45° FOV.
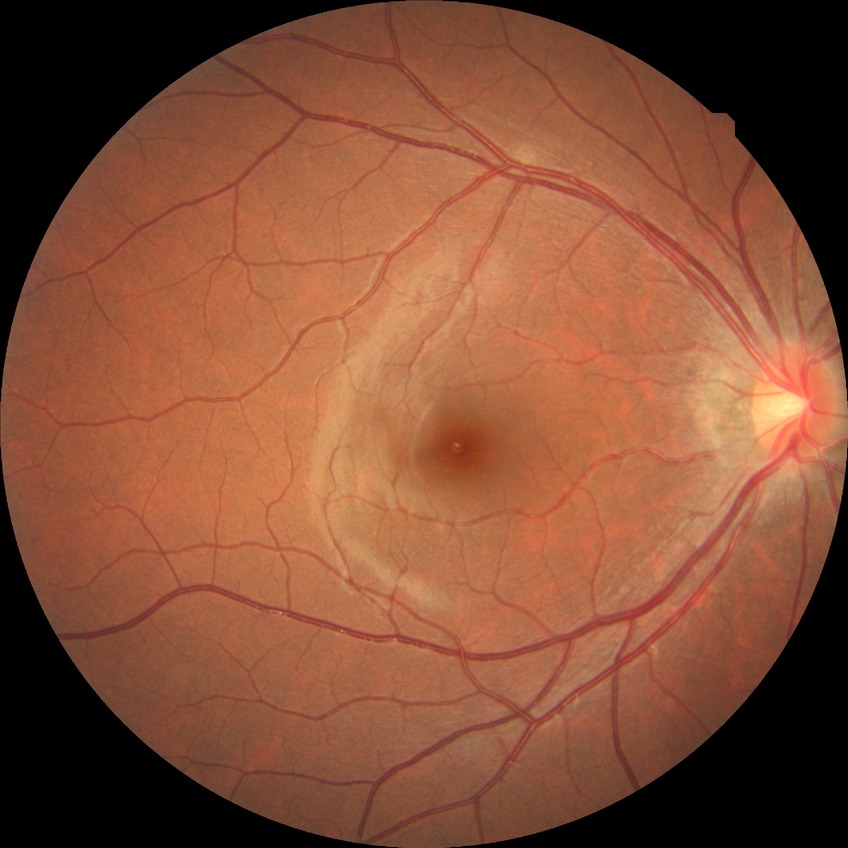 Davis grading is no diabetic retinopathy.